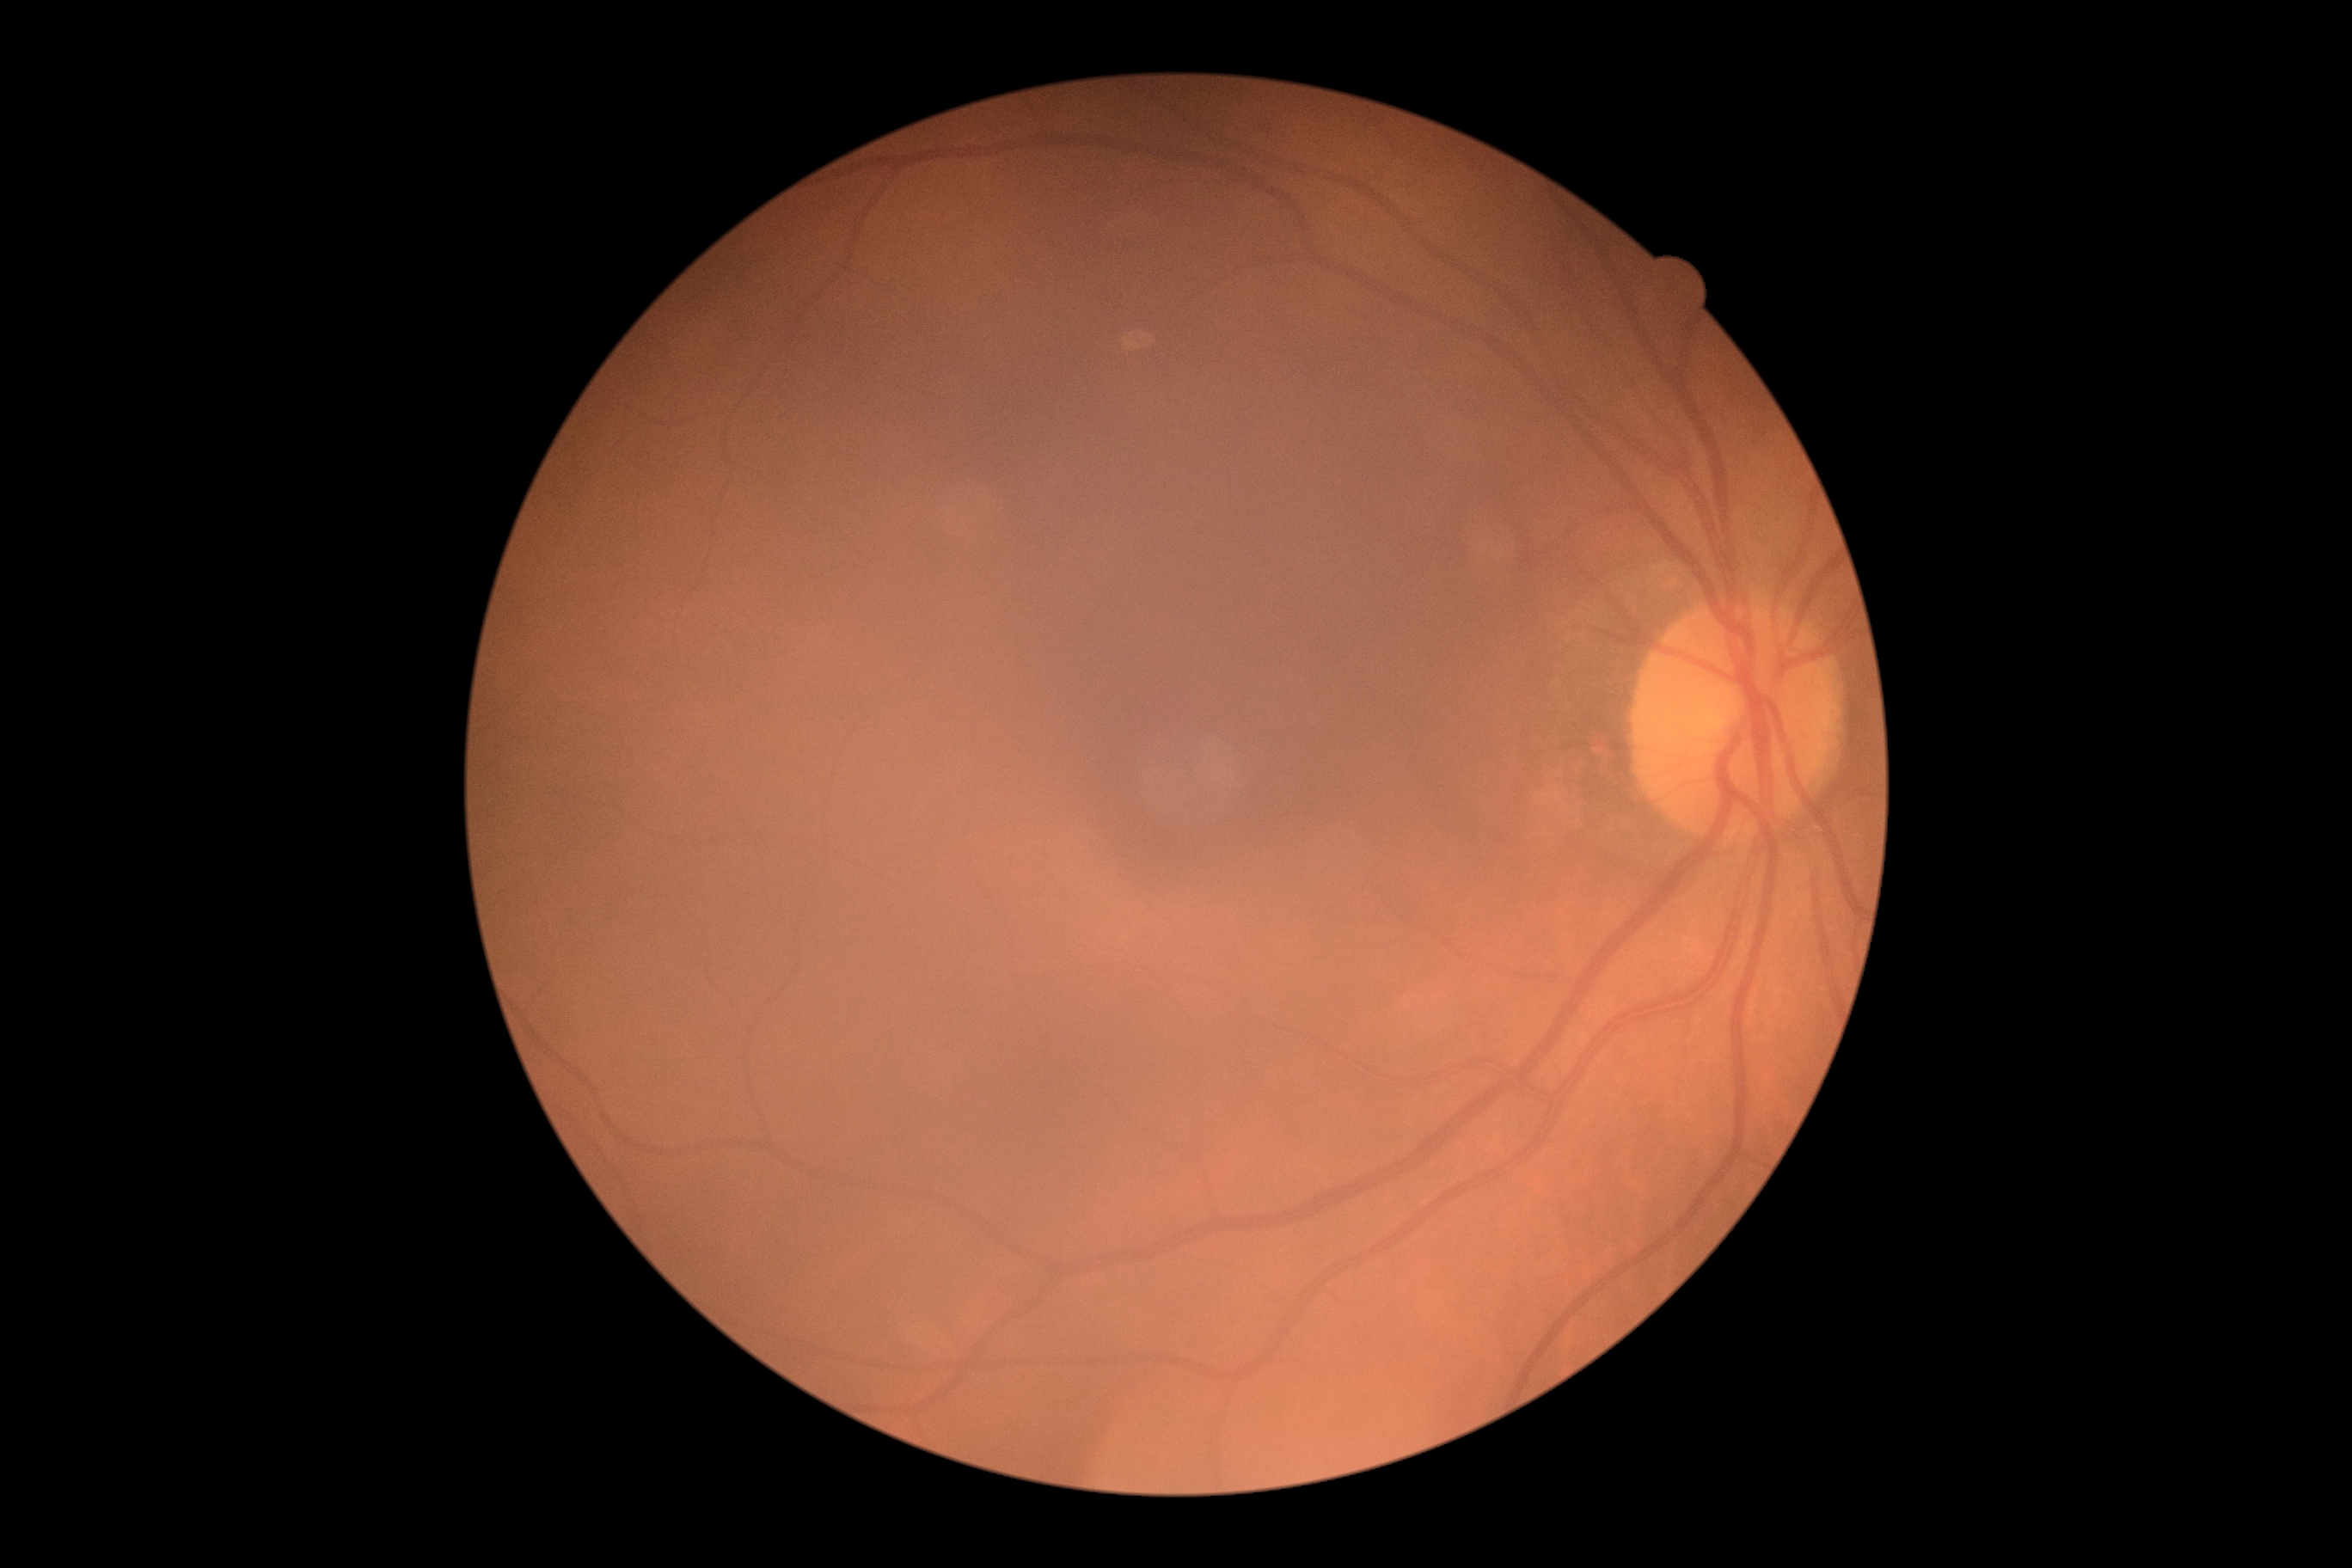

{
  "dr_grade": "0",
  "dr_impression": "no DR findings"
}